Captured with the Clarity RetCam 3 (130° field of view). Infant wide-field retinal image:
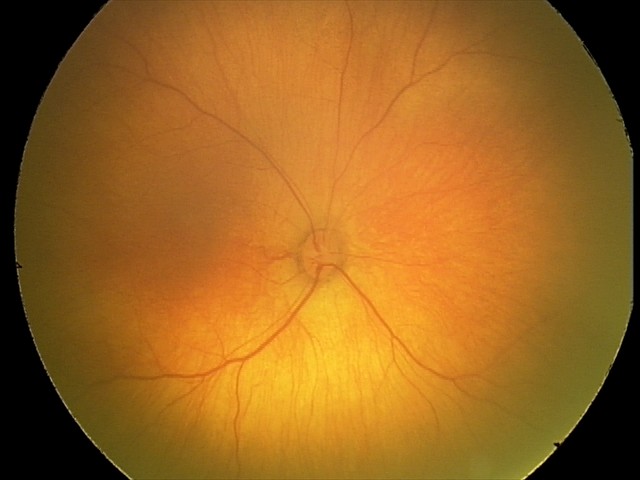

Assessment = normal.